CFP:
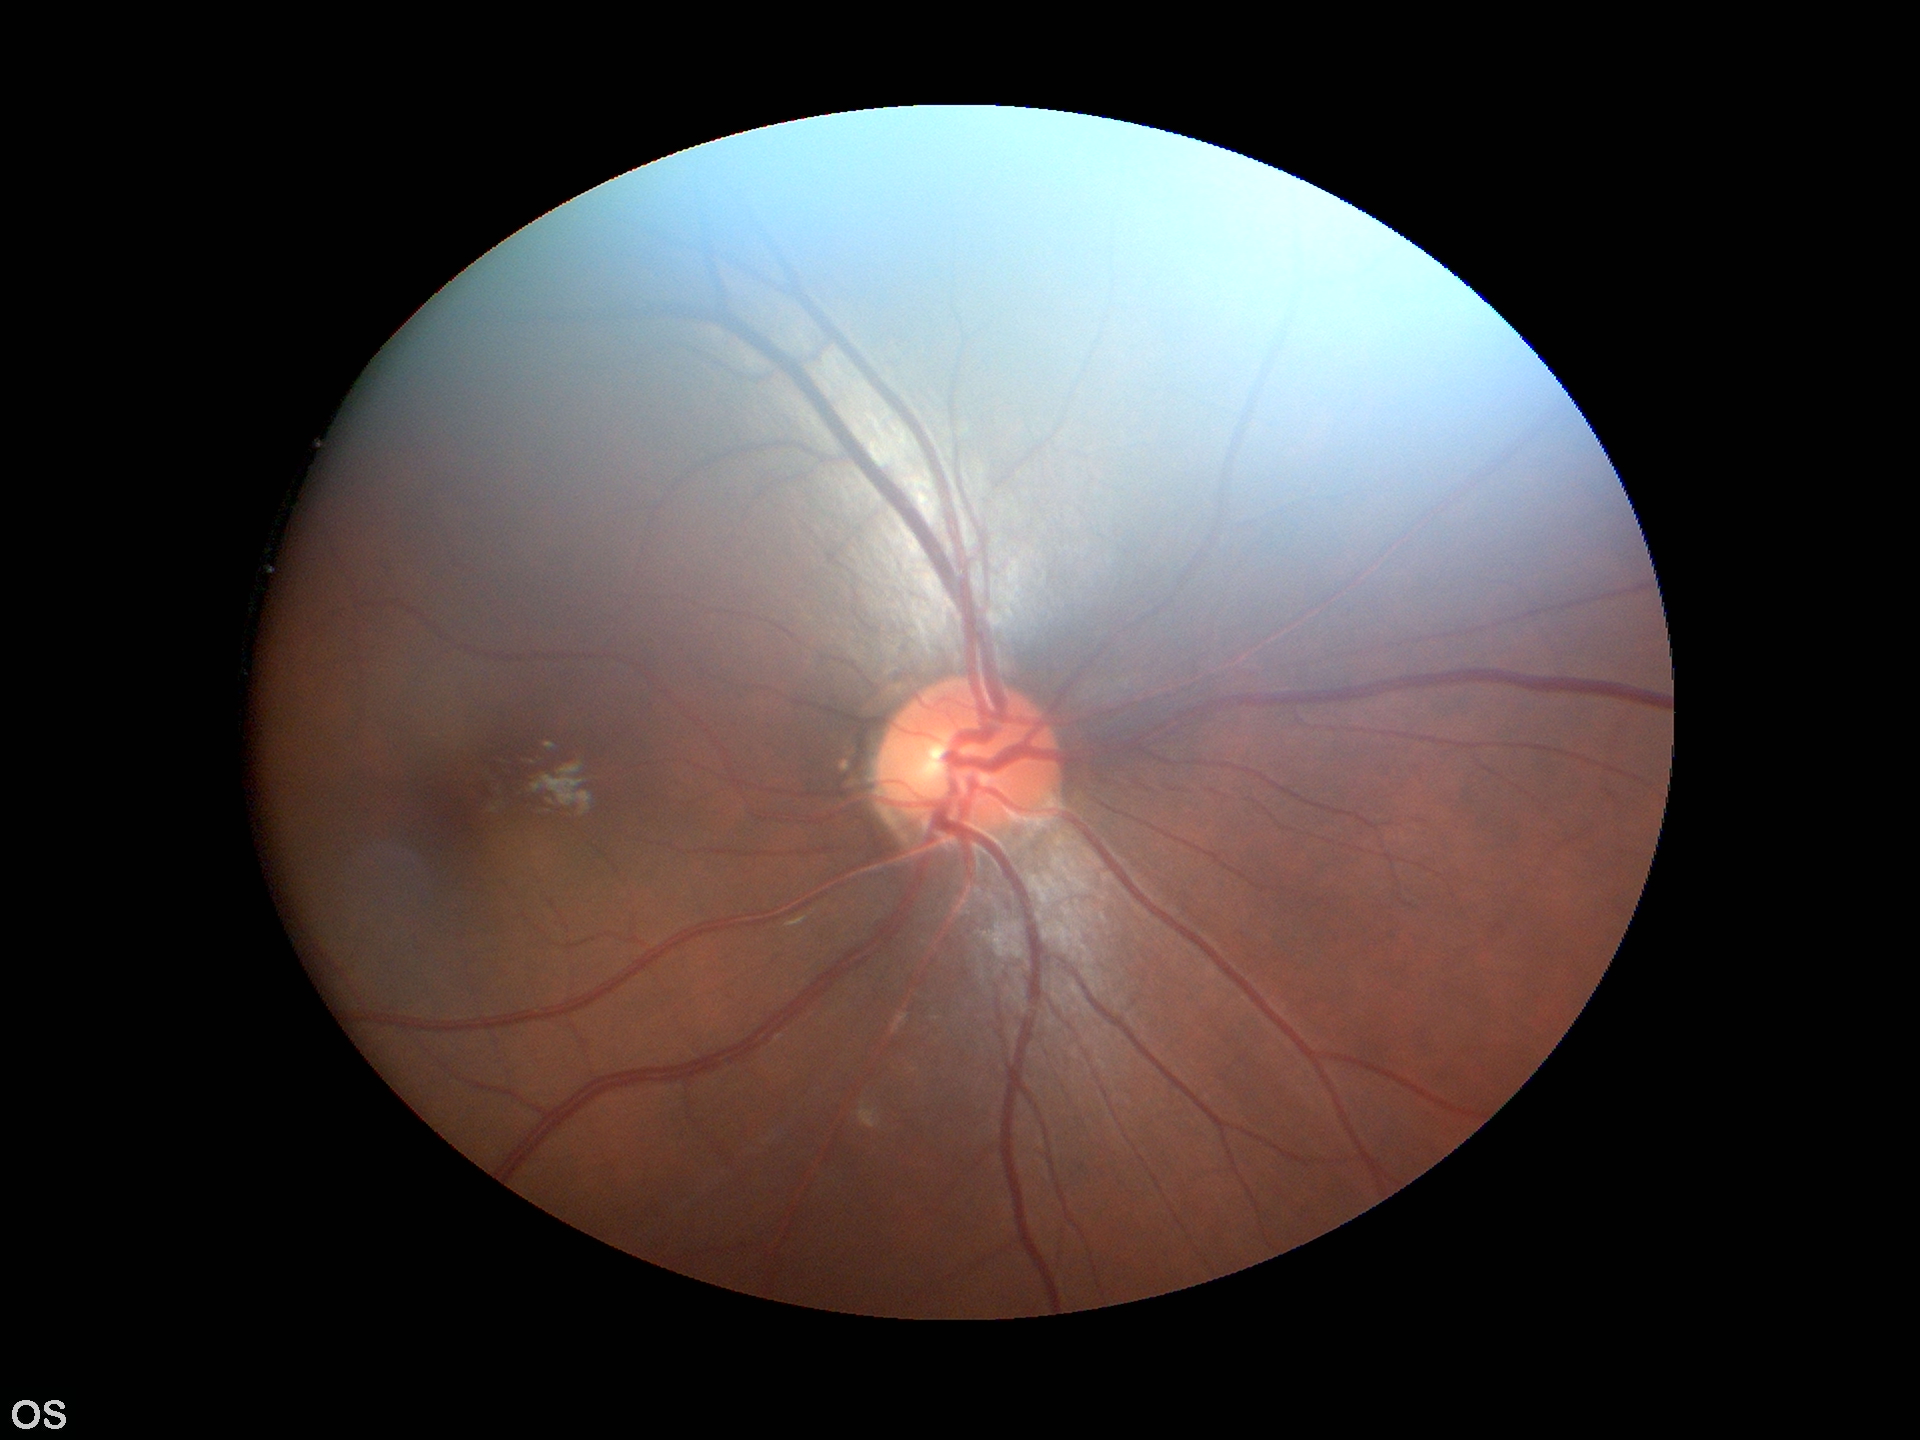
vertical C/D ratio: 0.38
Glaucoma screening: negative
horizontal CDR: 0.40